1960 by 1897 pixels.
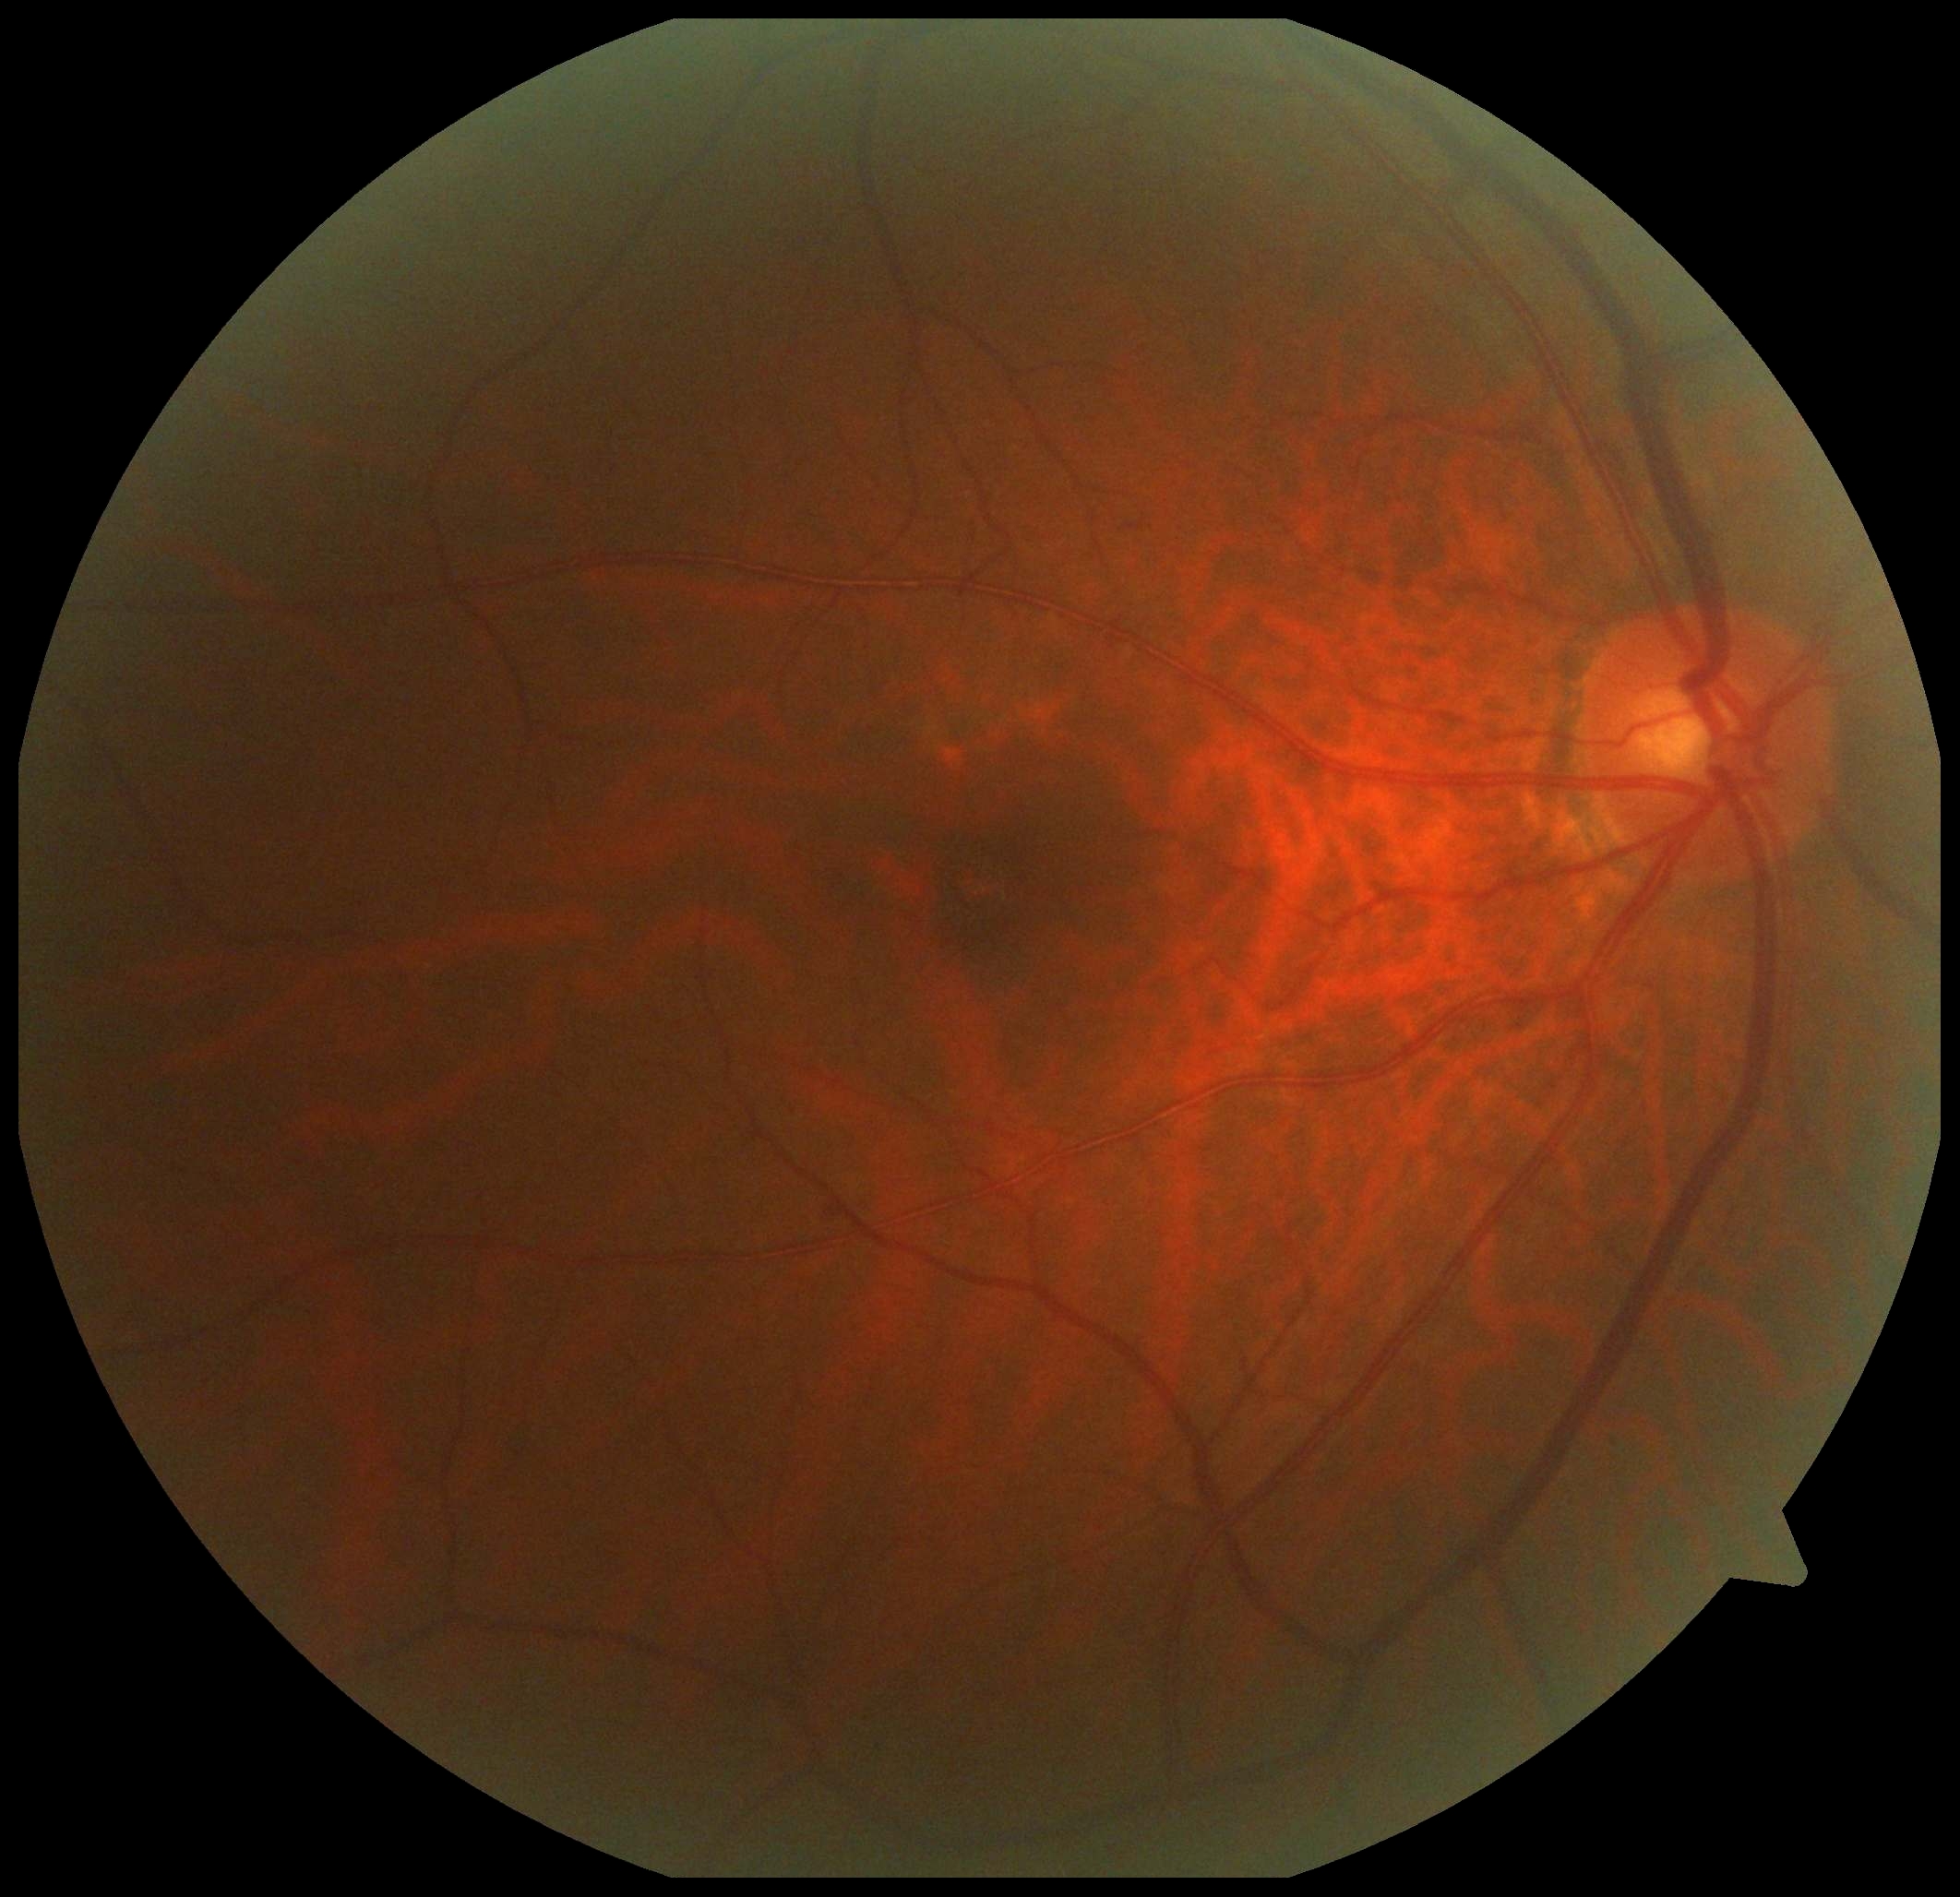 DR: grade 0 (no apparent retinopathy).